45-degree field of view · NIDEK AFC-230 fundus camera.
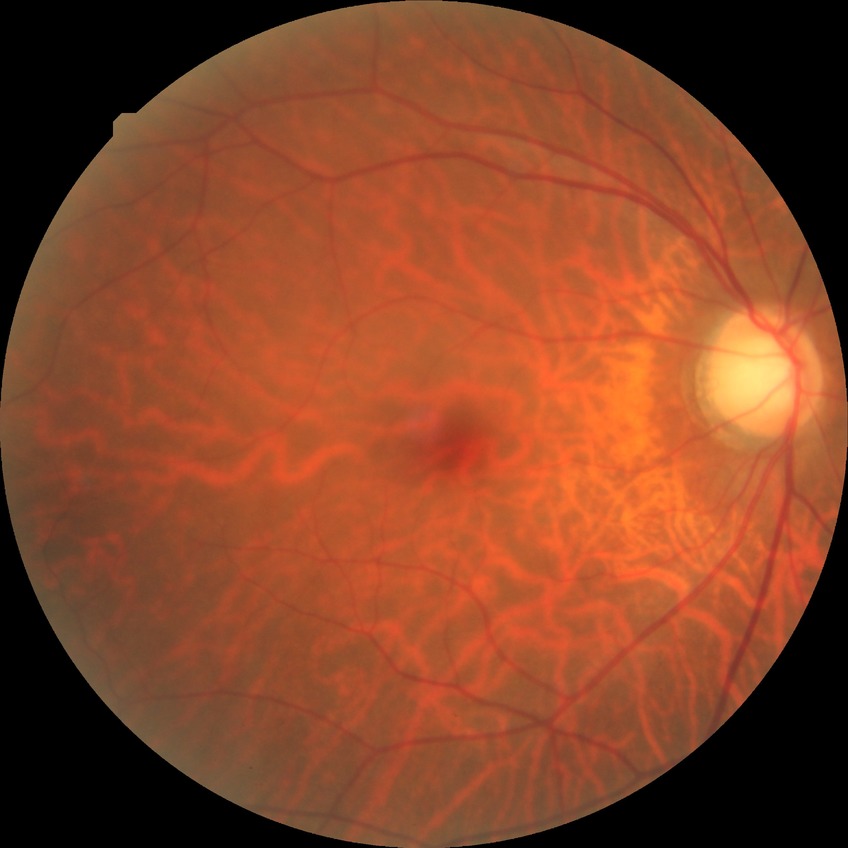 * Davis DR grade — NDR